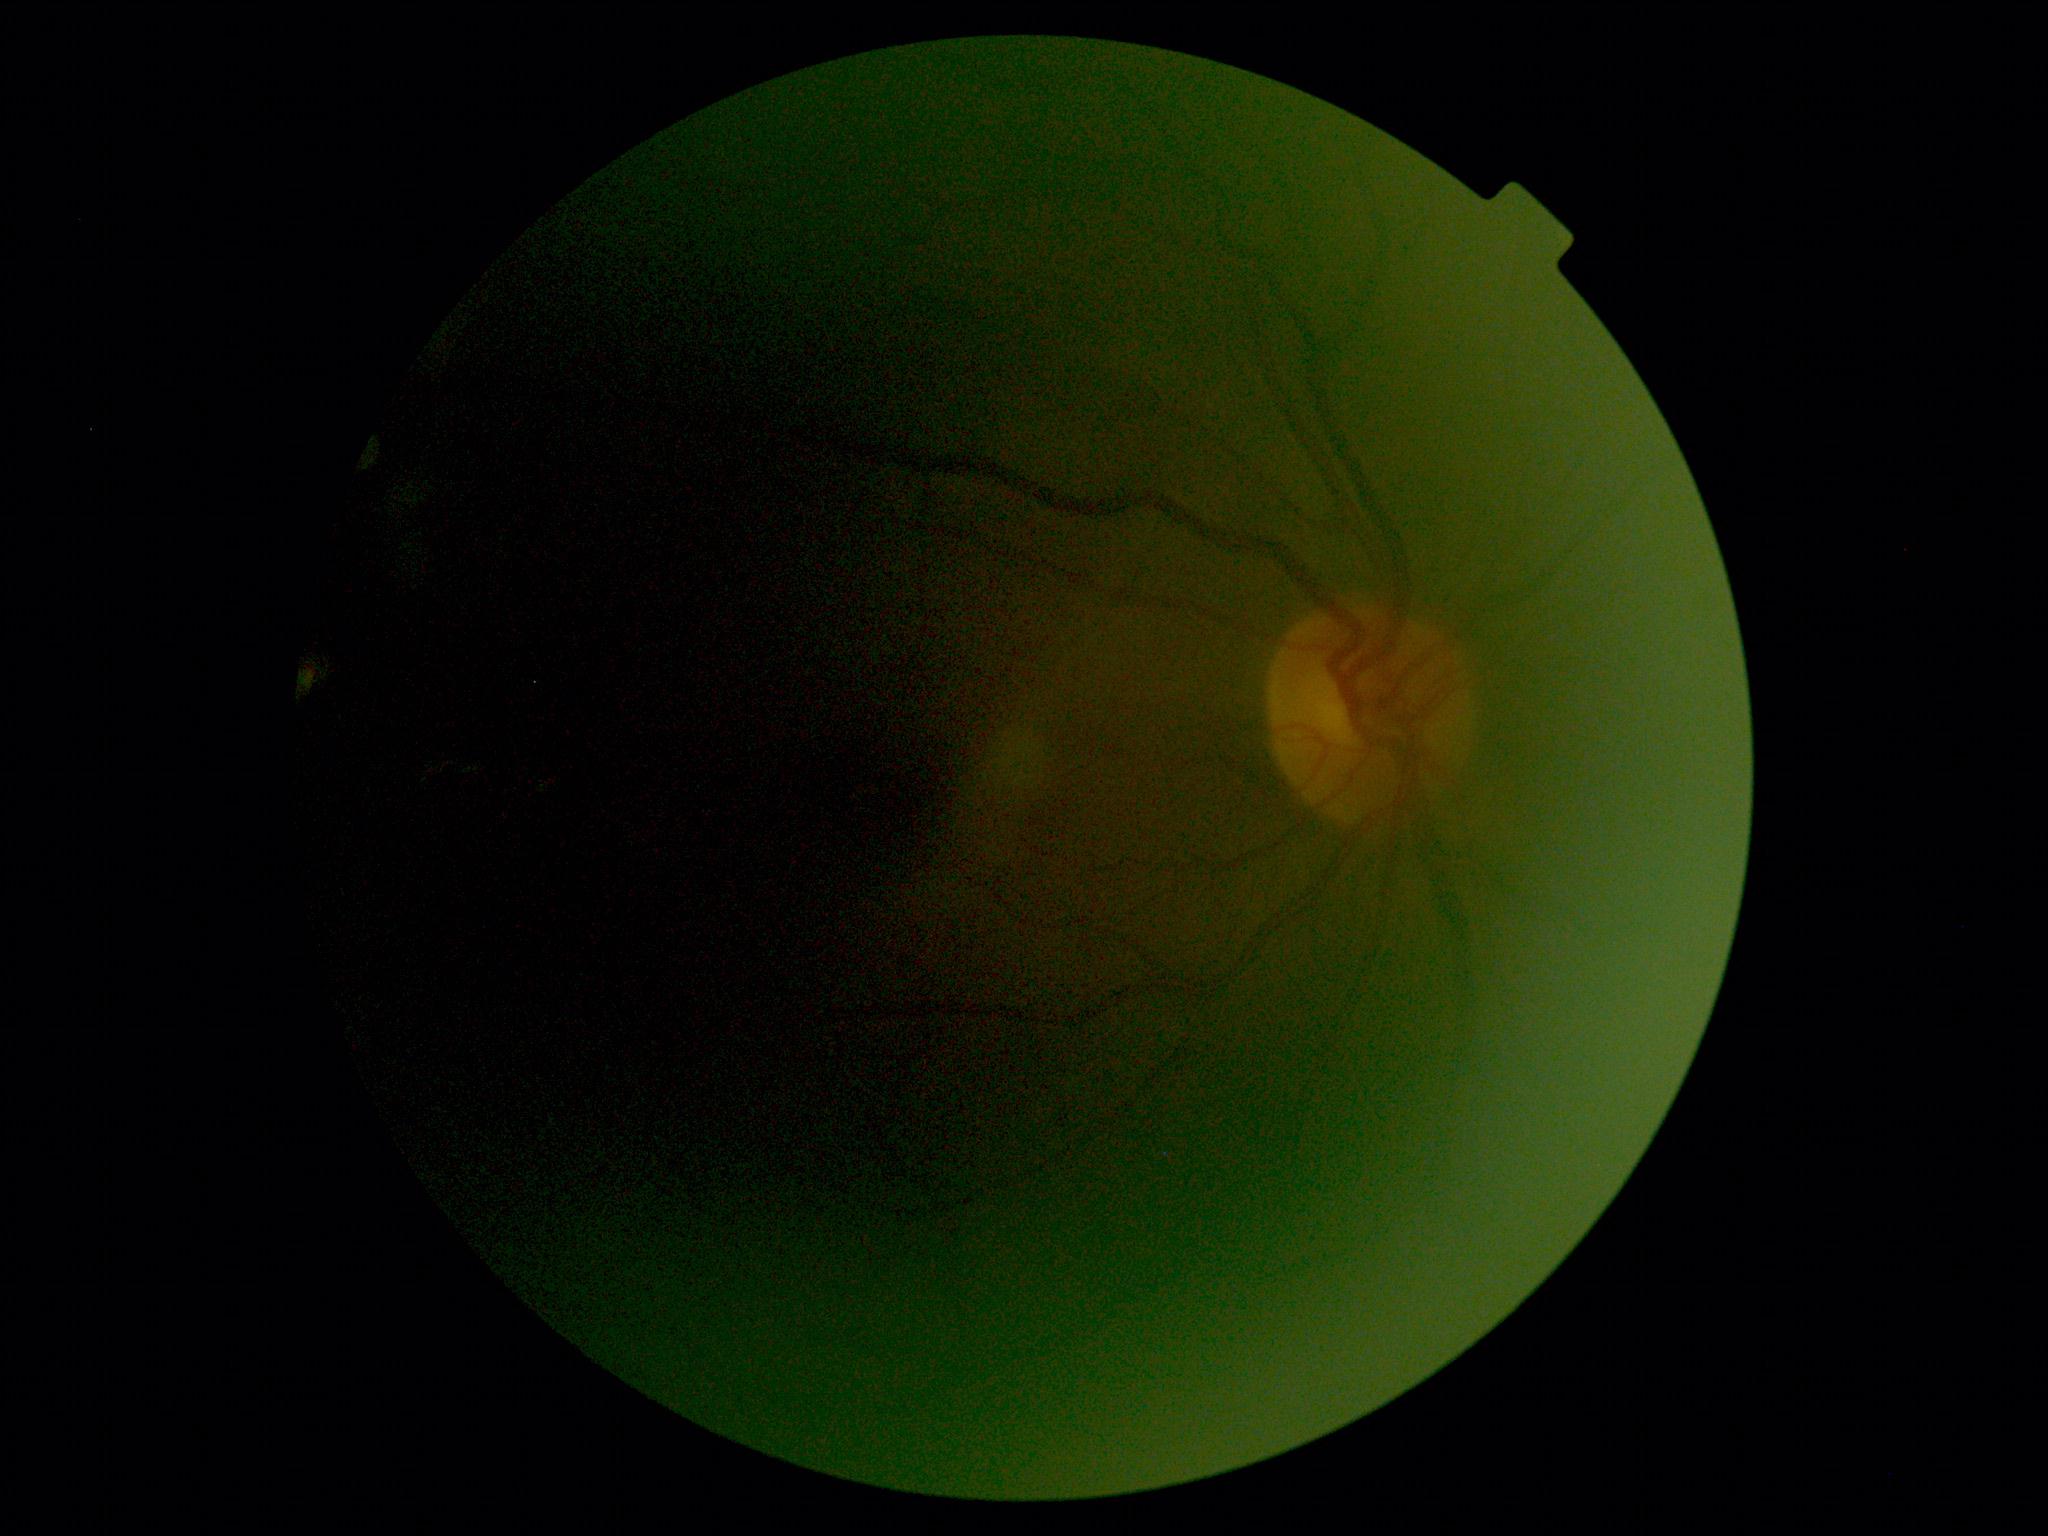

Findings:
– diabetic retinopathy severity: ungradable due to poor image quality
– image quality: too poor for DR grading